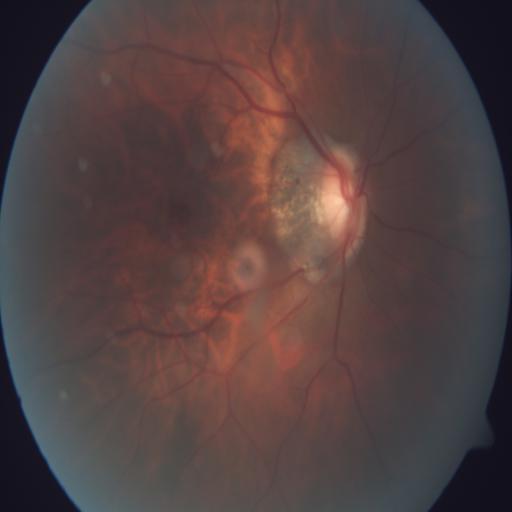 Diagnosis: TD (tilted disc).